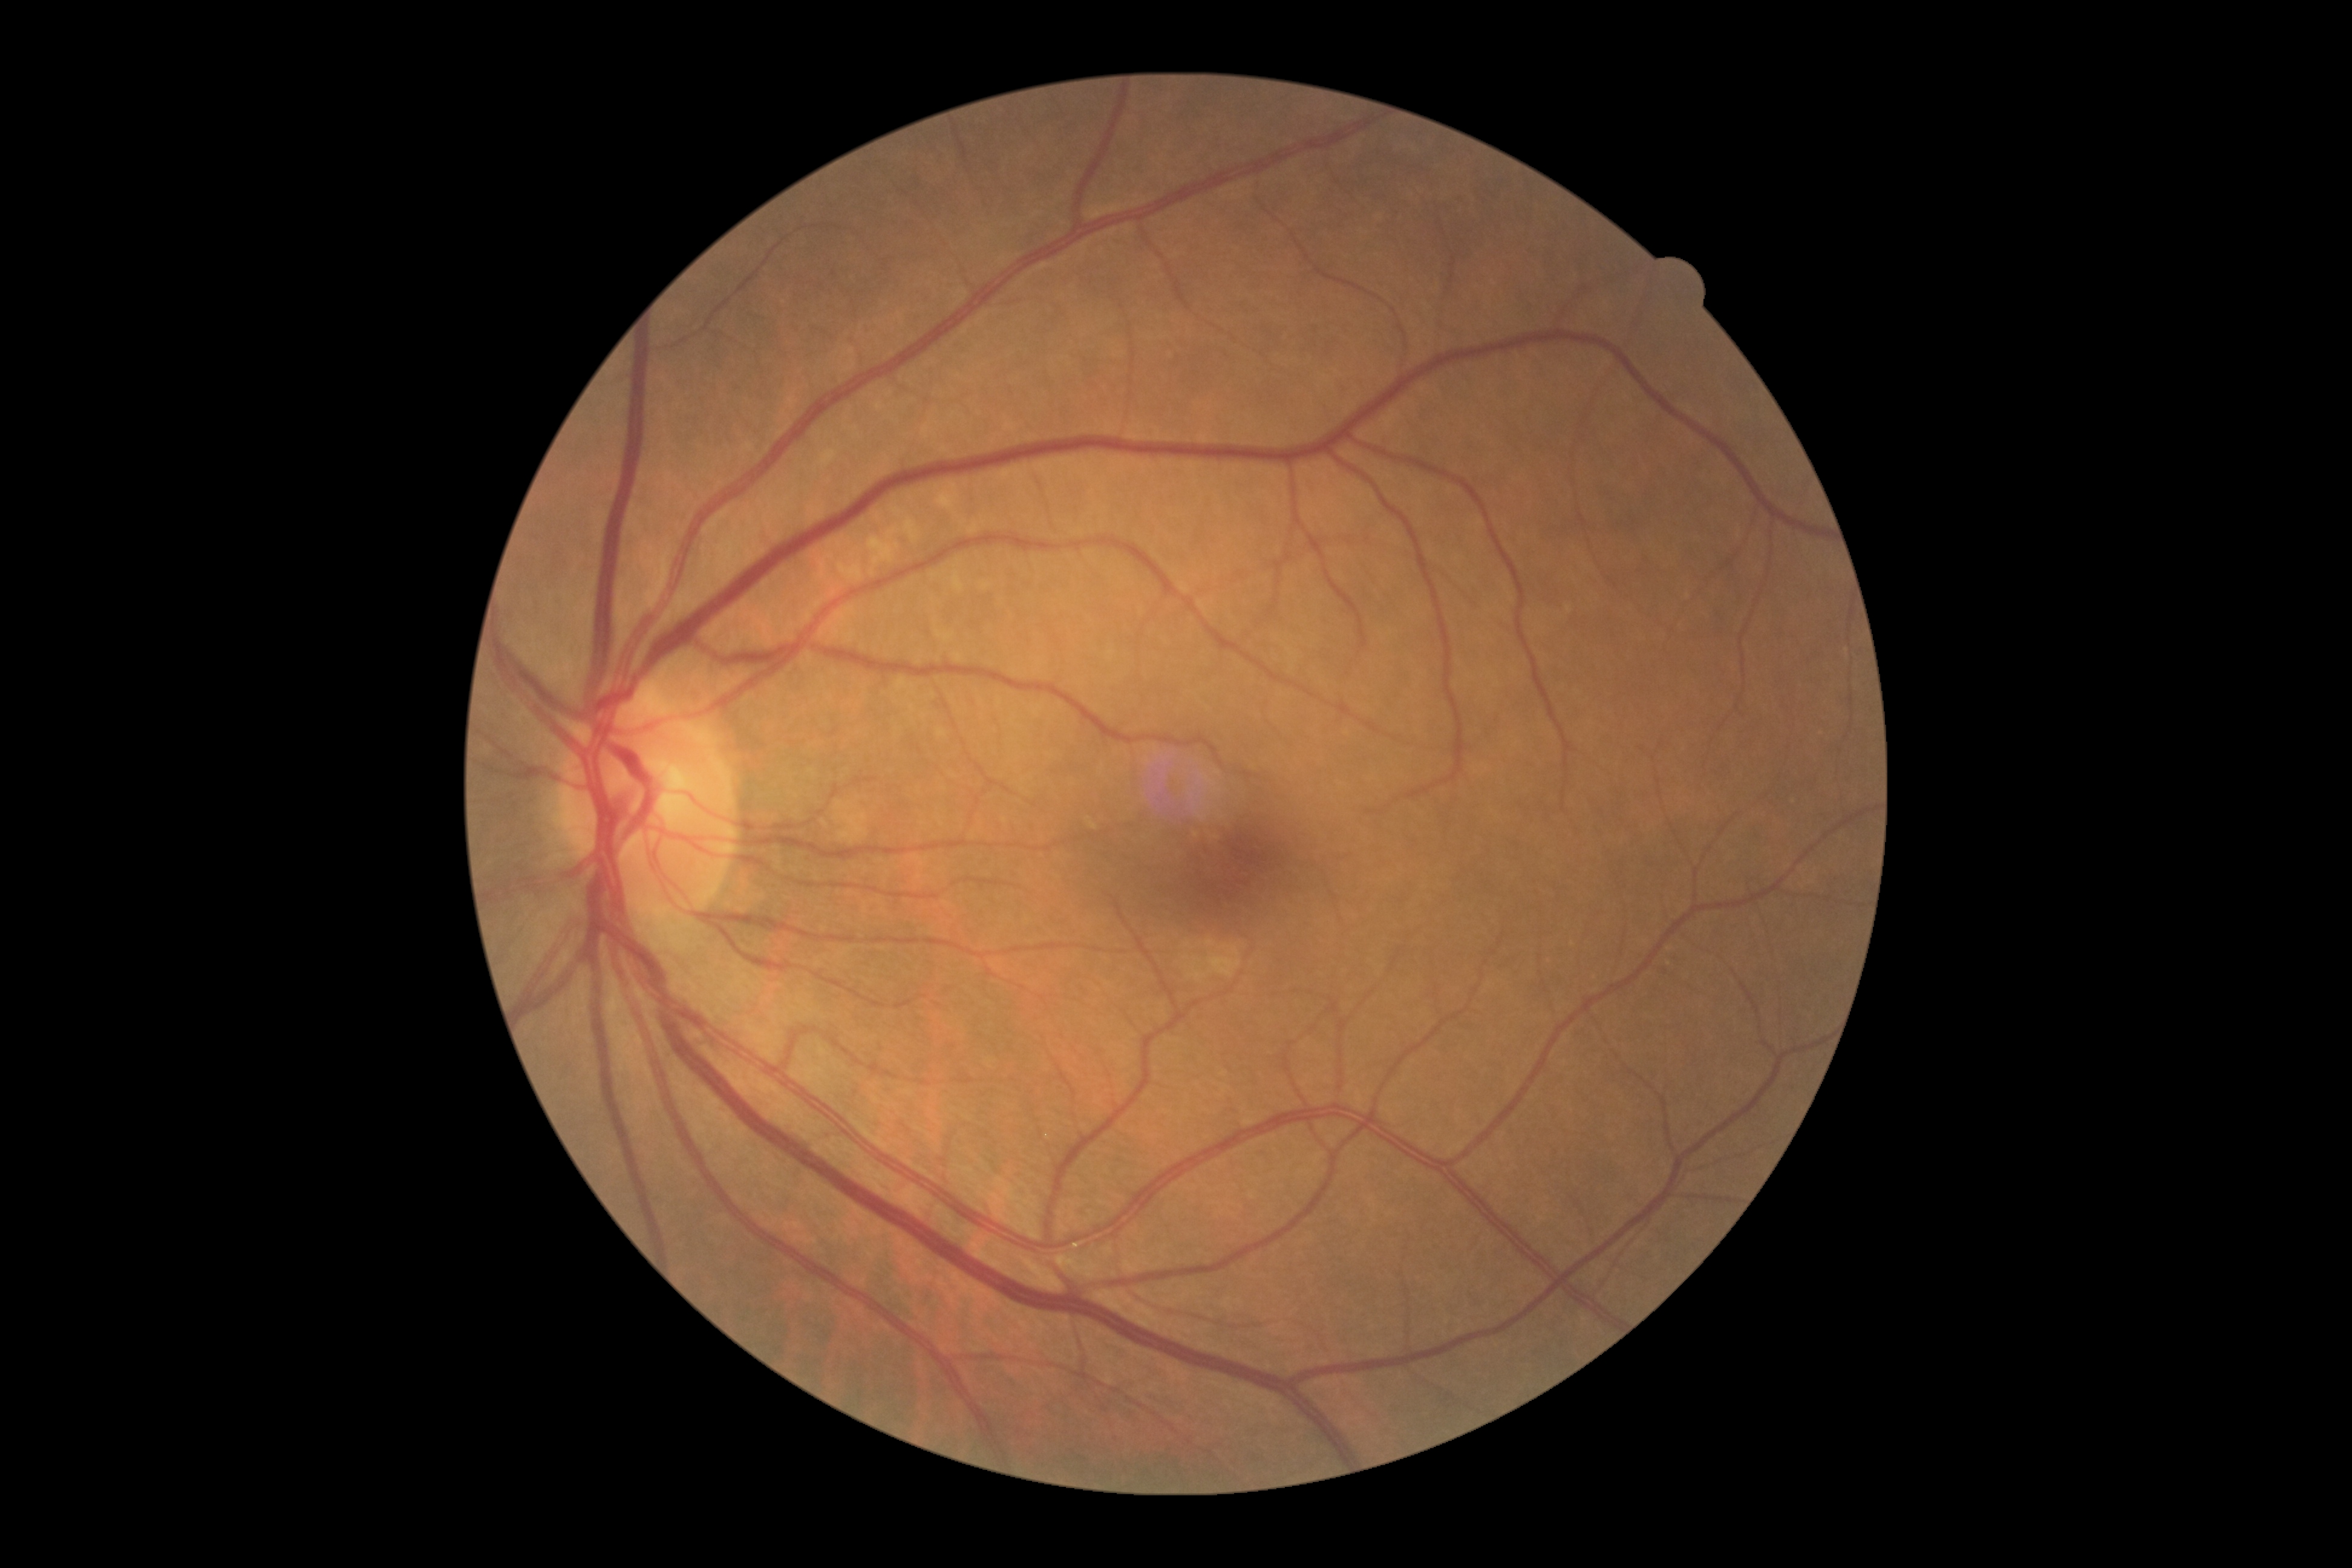

Findings:
- DR severity: 0 — no visible signs of diabetic retinopathy